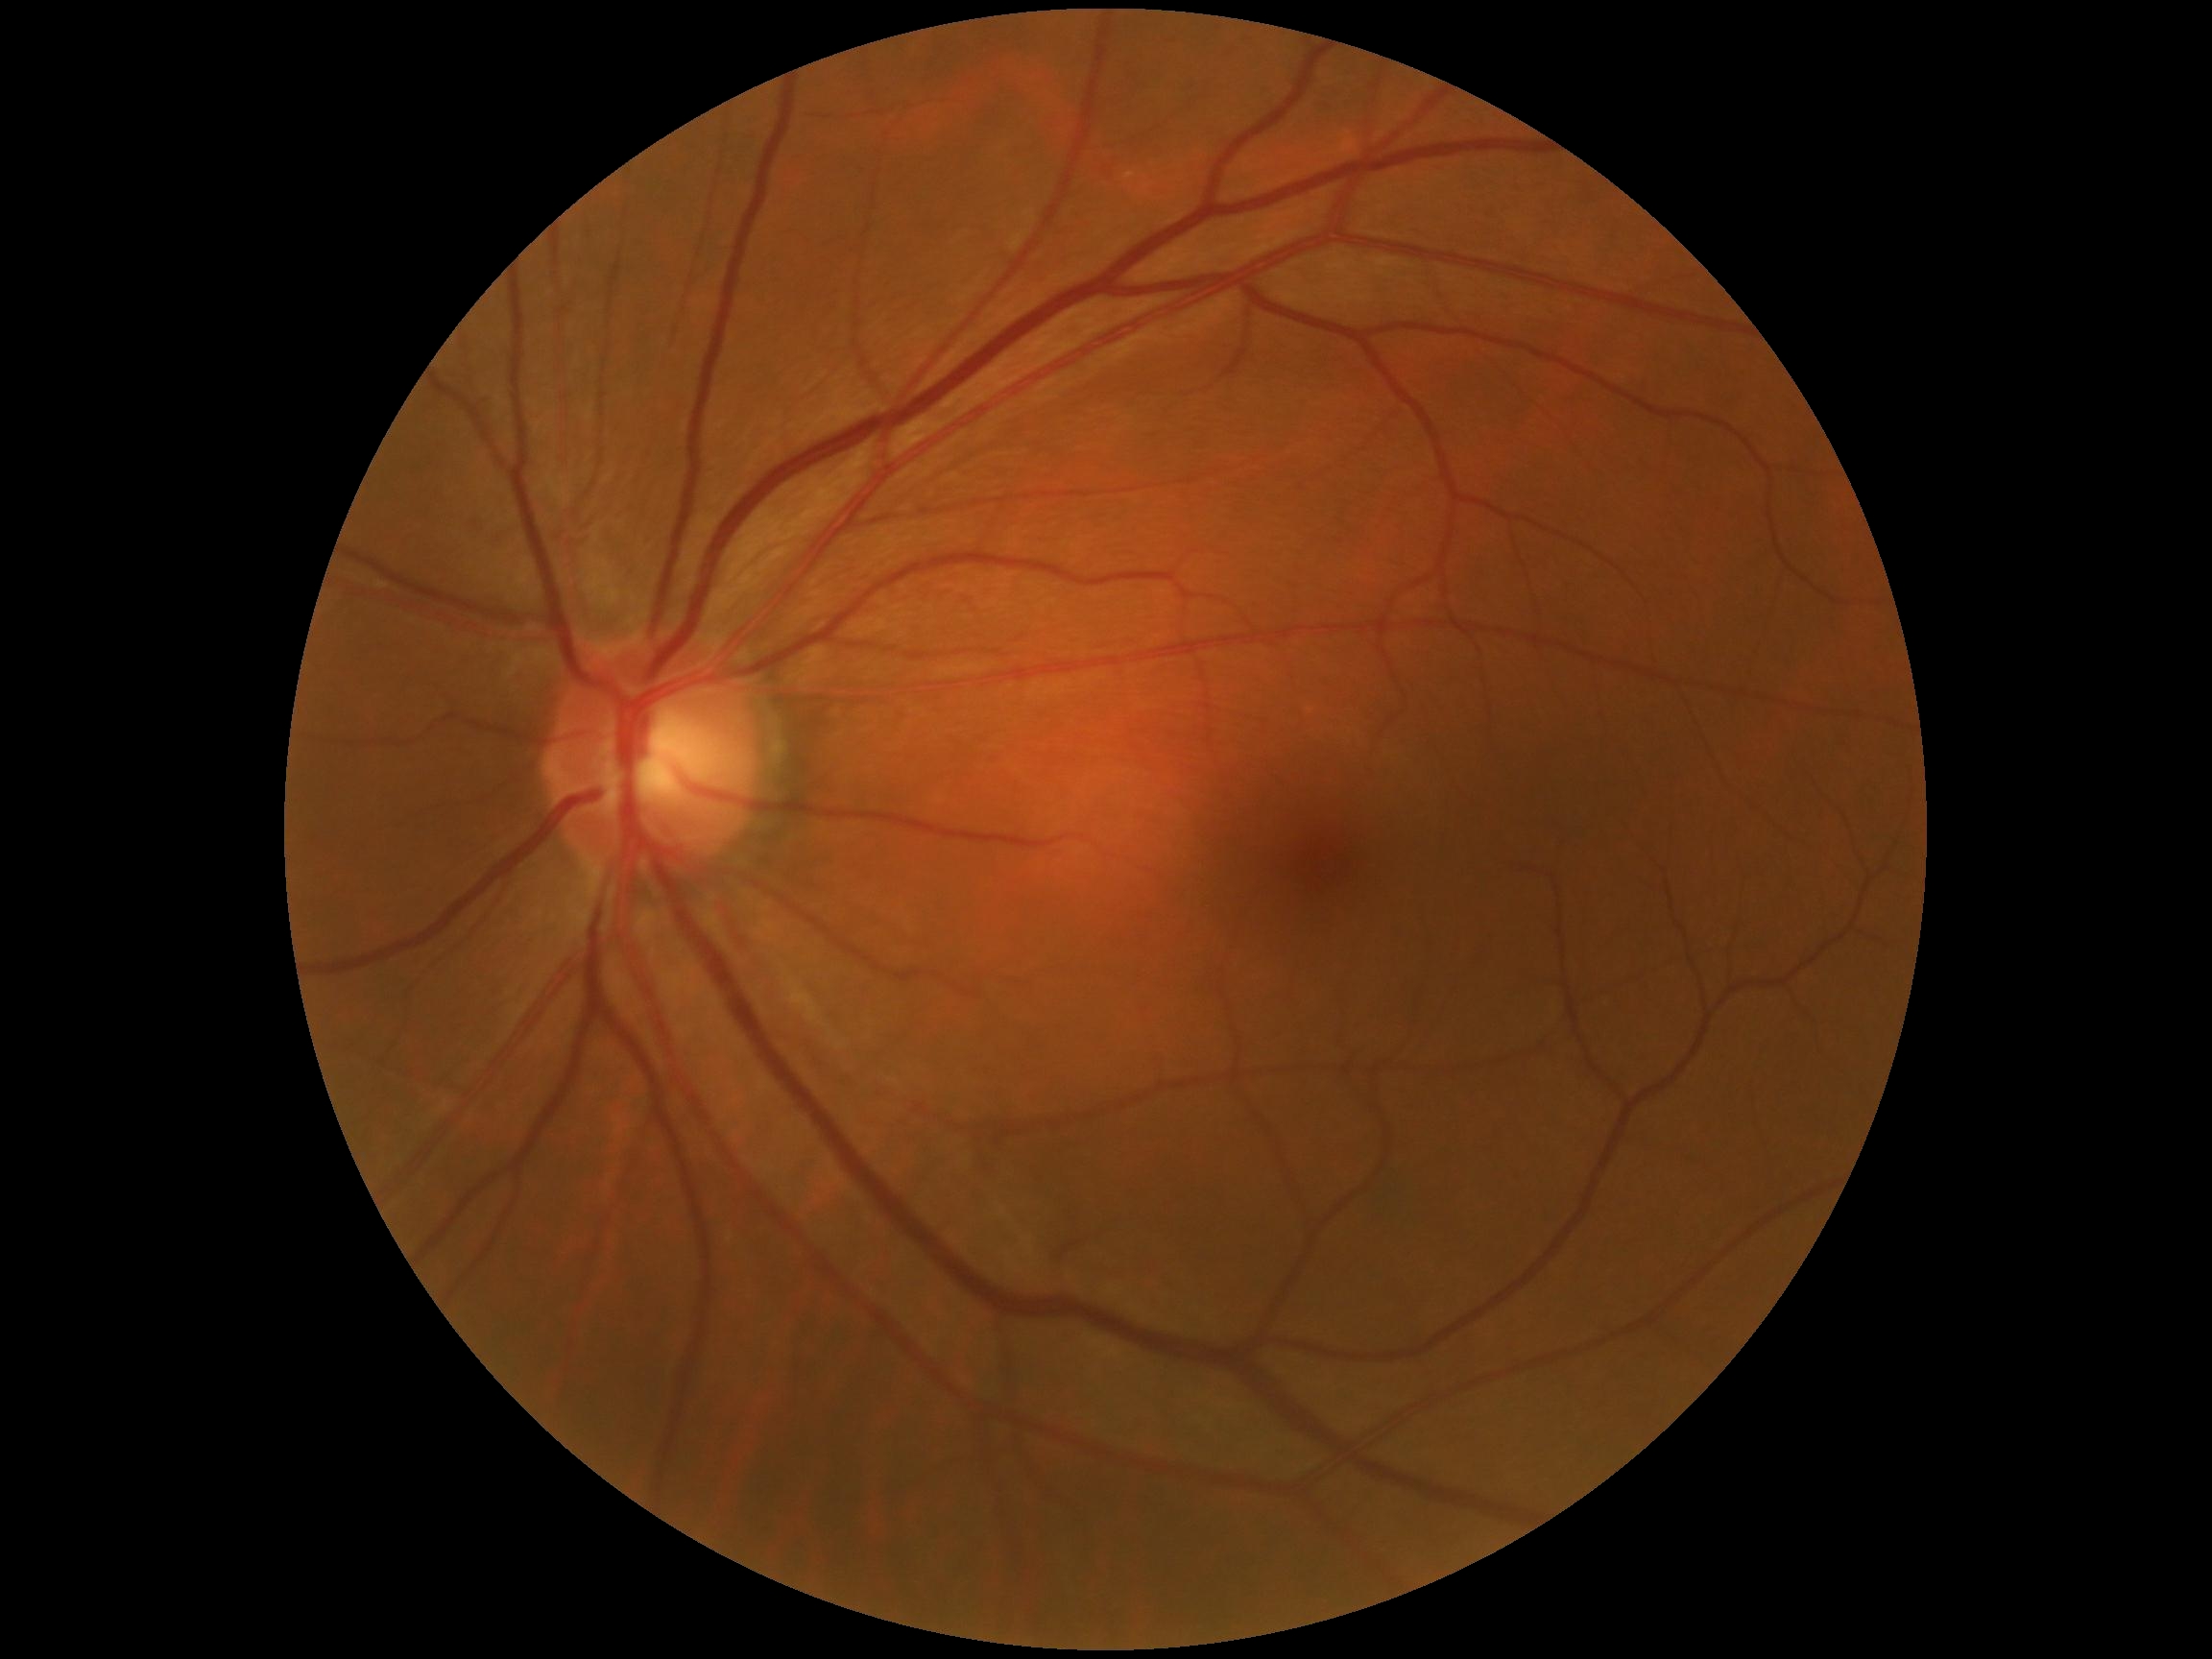

Diabetic retinopathy severity is 0.
No DR findings.